Cropped from a 35-degree field of view; optic nerve head photograph; mydriatic acquisition:
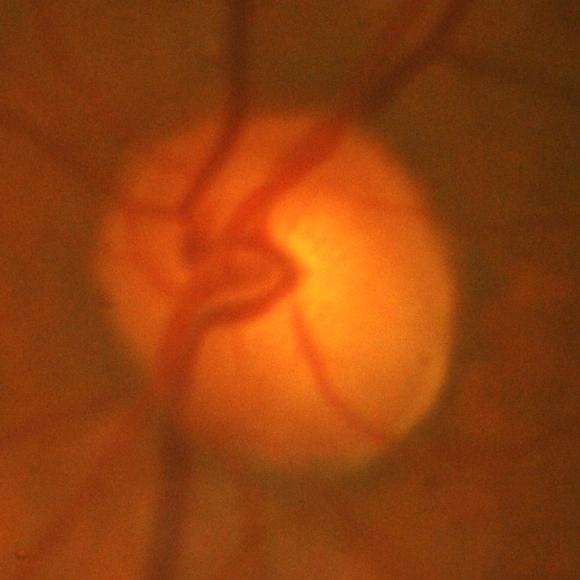

Impression: glaucomatous damage to the optic nerve.